640x480px; pediatric wide-field fundus photograph — 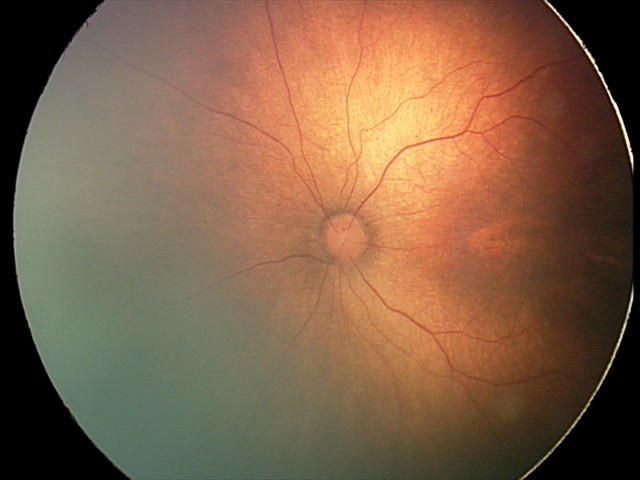
Screening: no plus disease; status post retinopathy of prematurity — retinal appearance after treated retinopathy of prematurity.